FOV: 45 degrees.
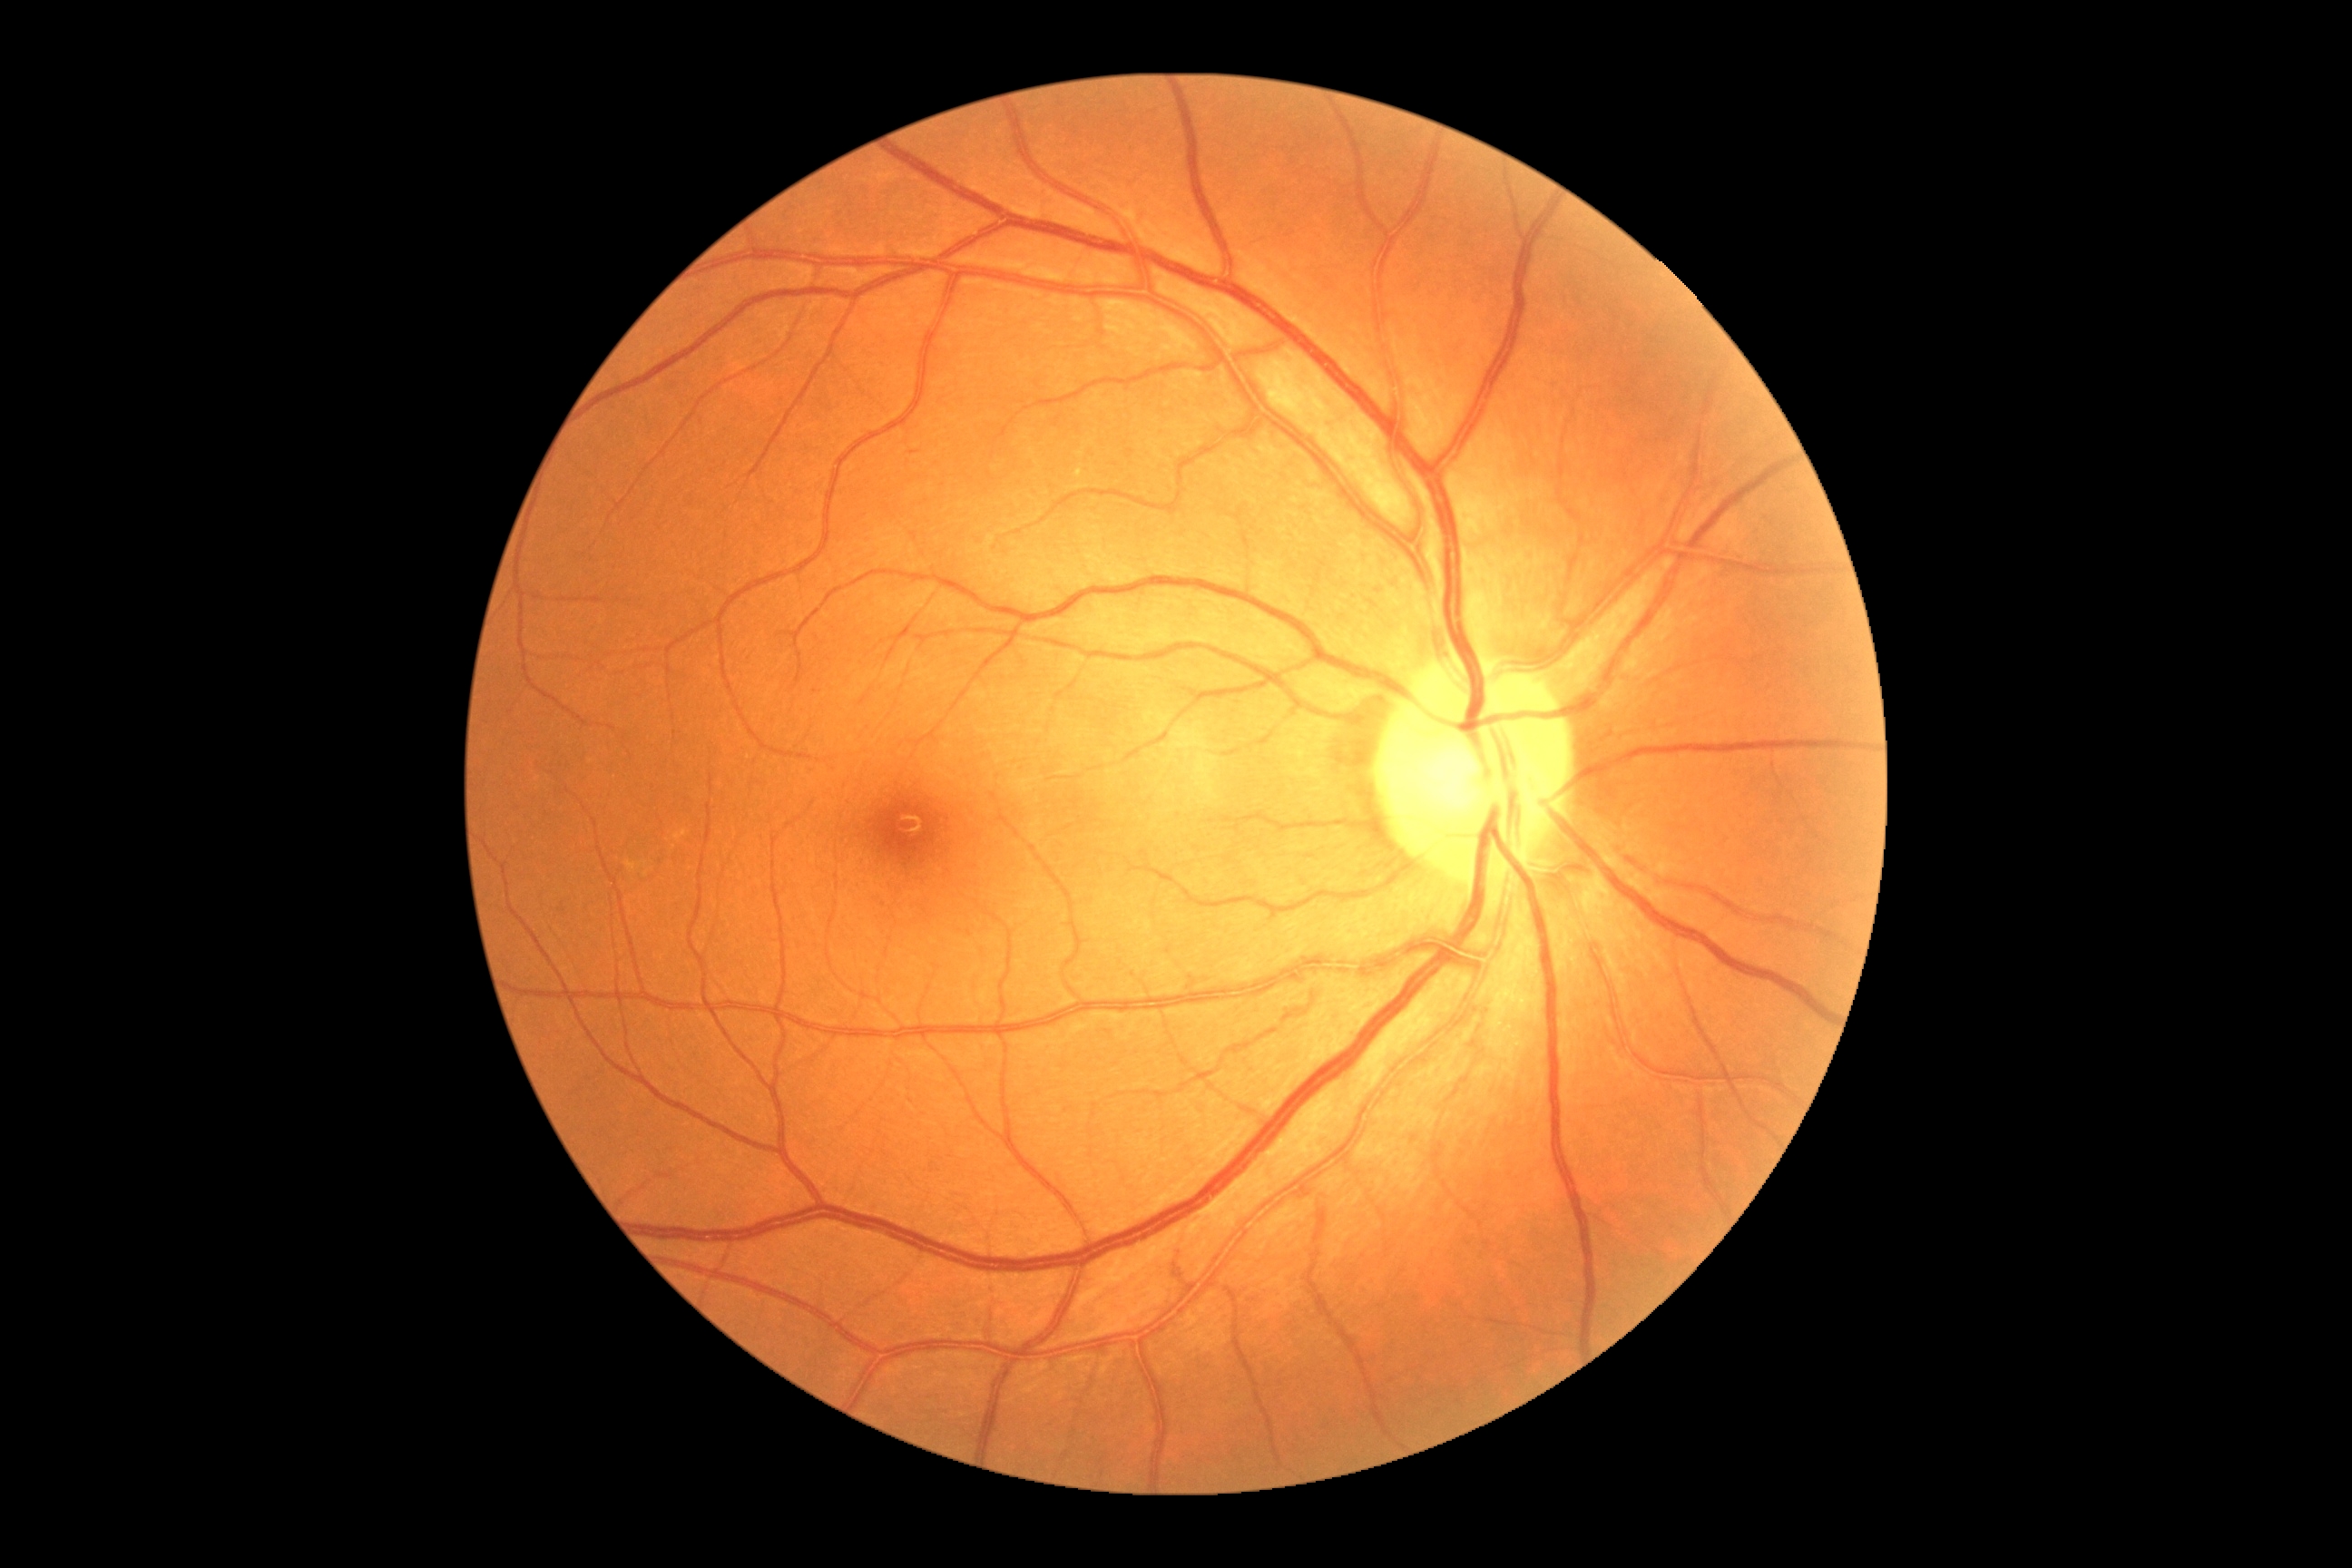
DR grade is 0.